FOV: 45 degrees.
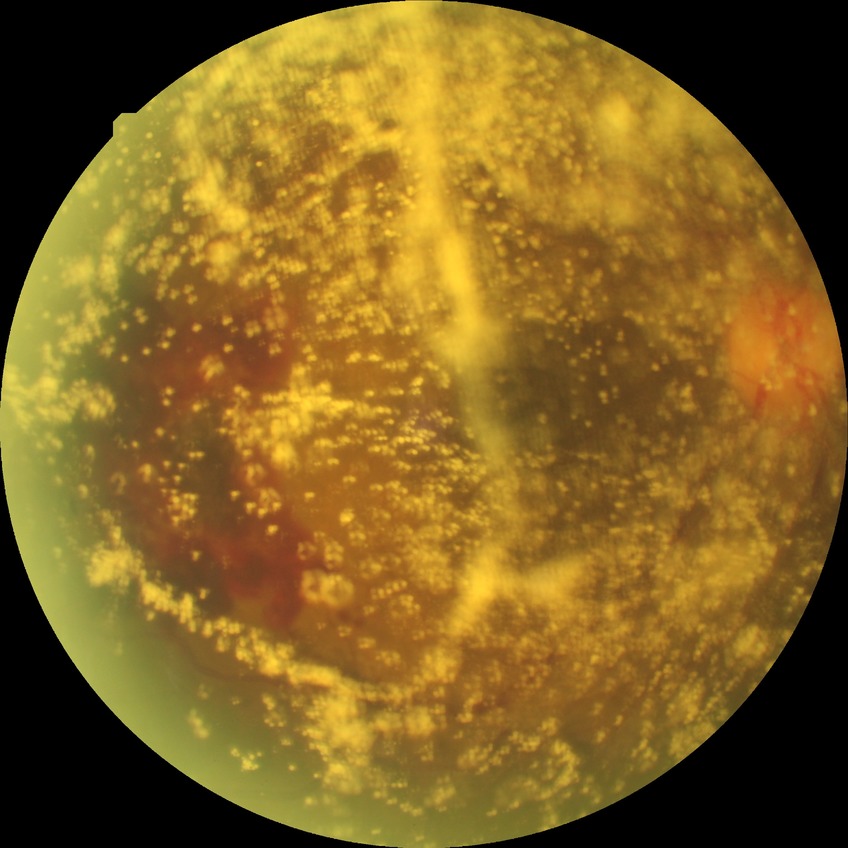 - modified Davis grade: PDR